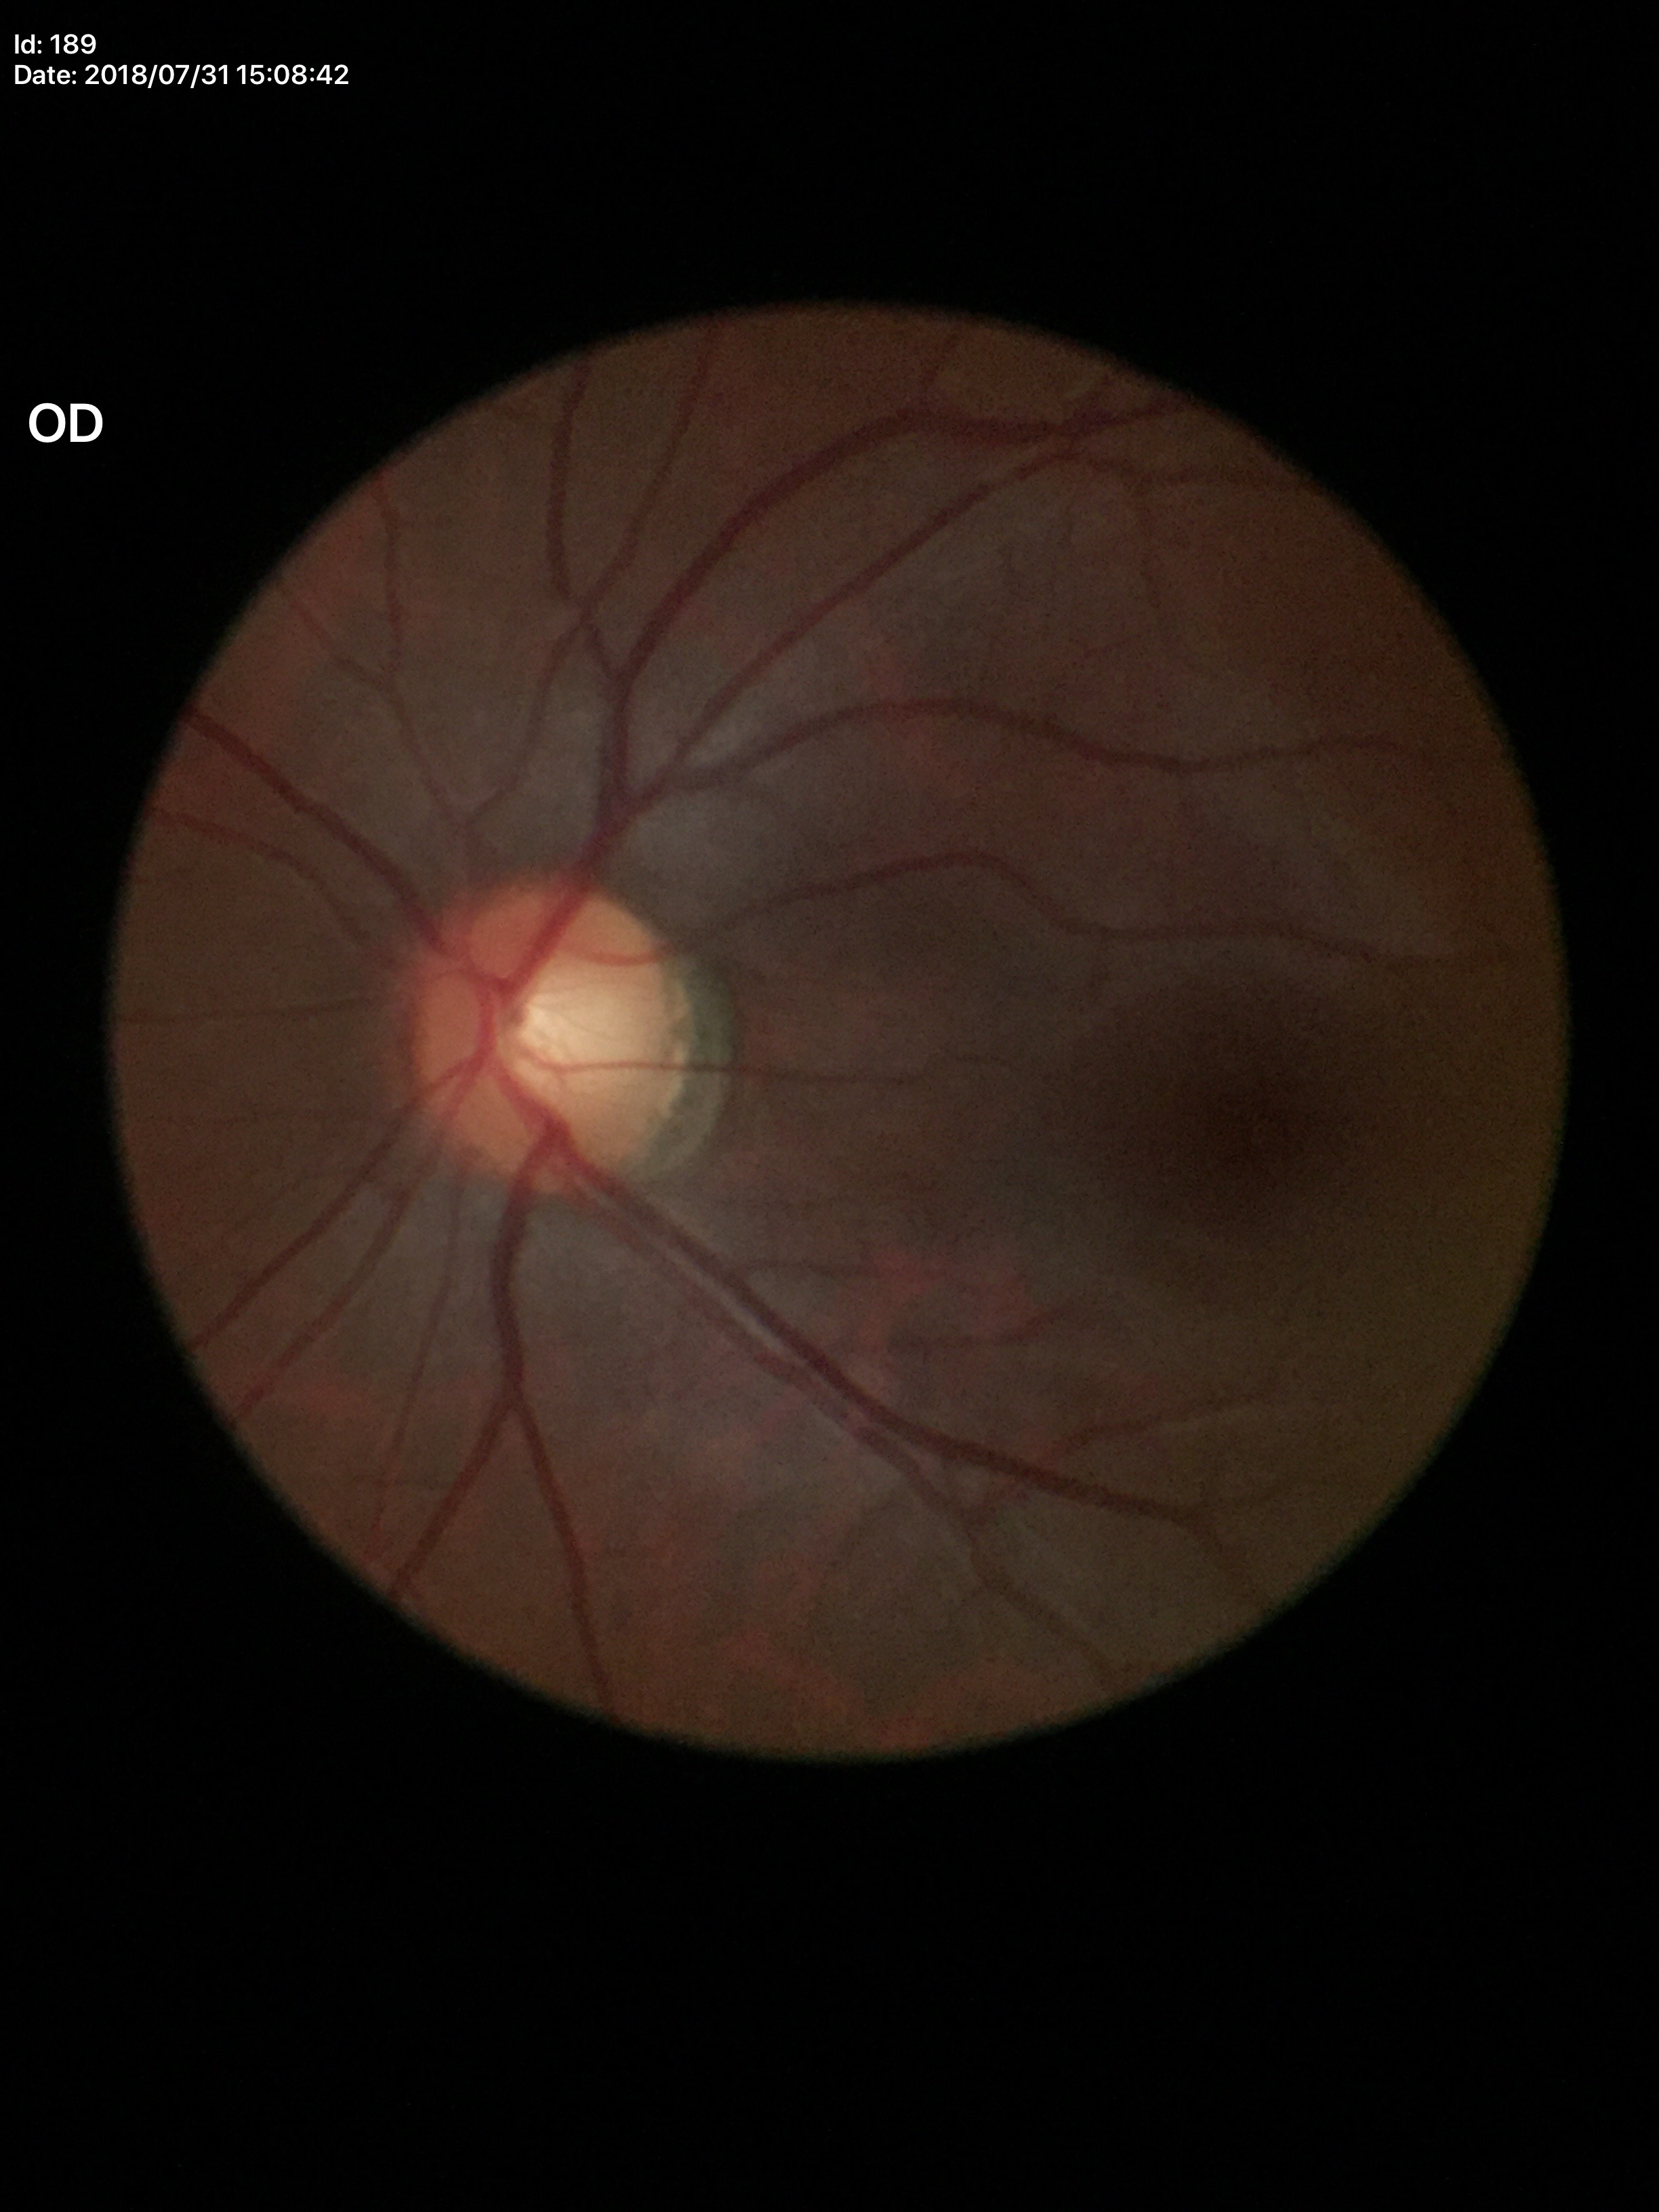
Glaucoma impression: no suspicious findings. Horizontal C/D ratio: 0.59. Vertical cup-disc ratio of 0.56.